Infant wide-field fundus photograph. Camera: Phoenix ICON (100° FOV)
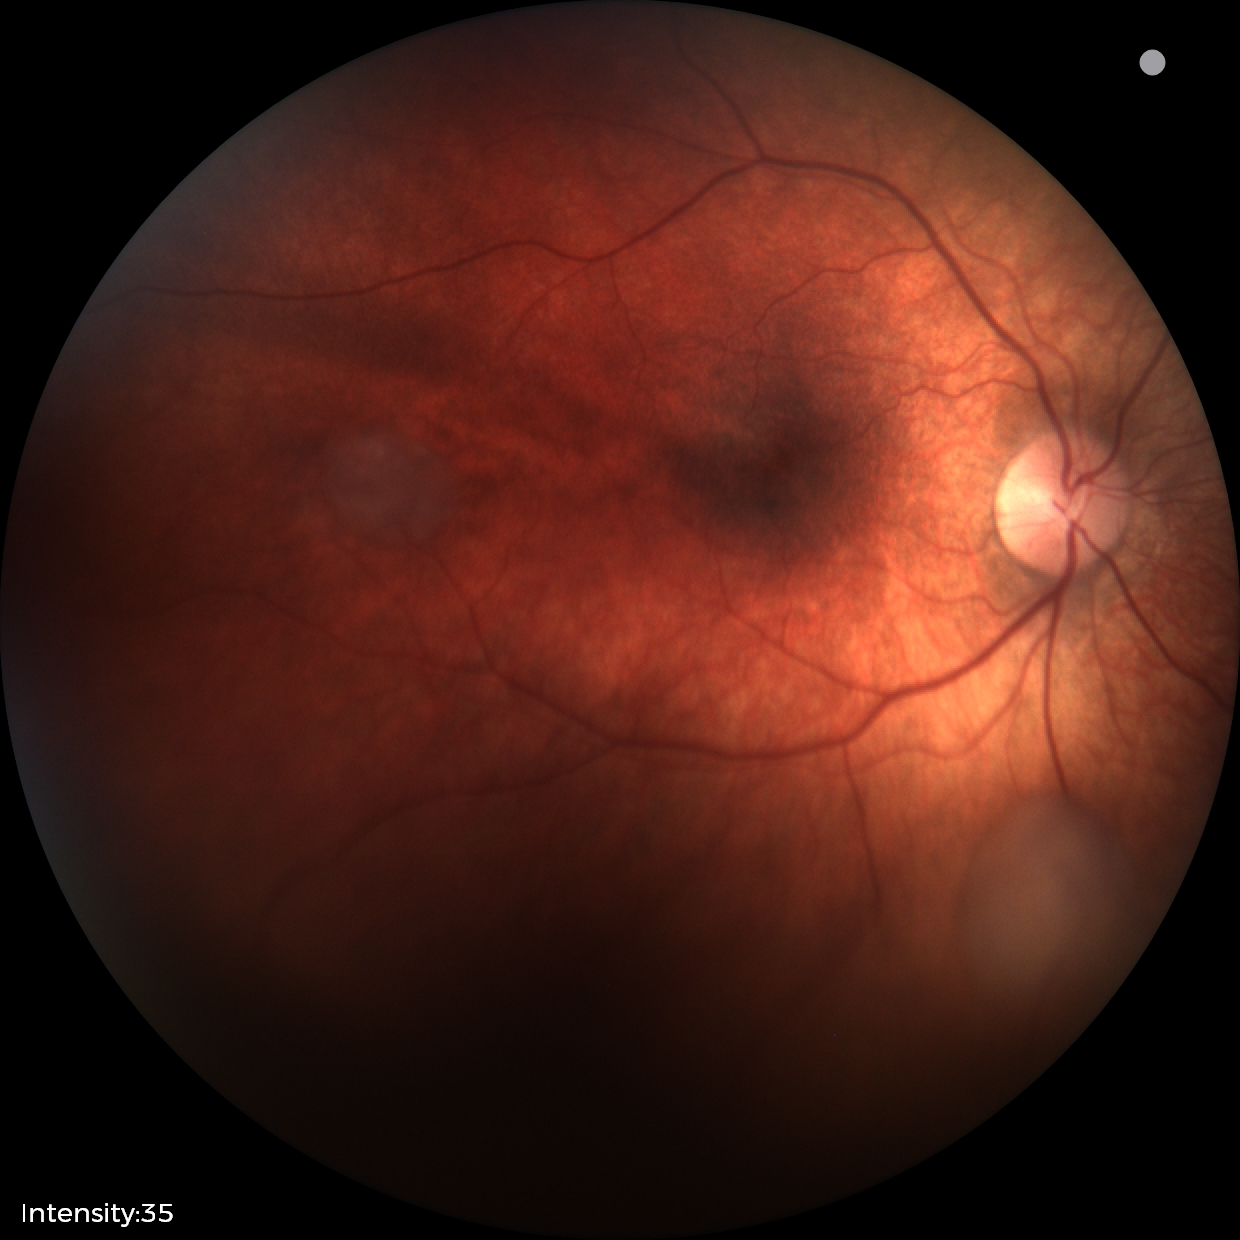 Screening diagnosis: retinal astrocytic hamartoma.